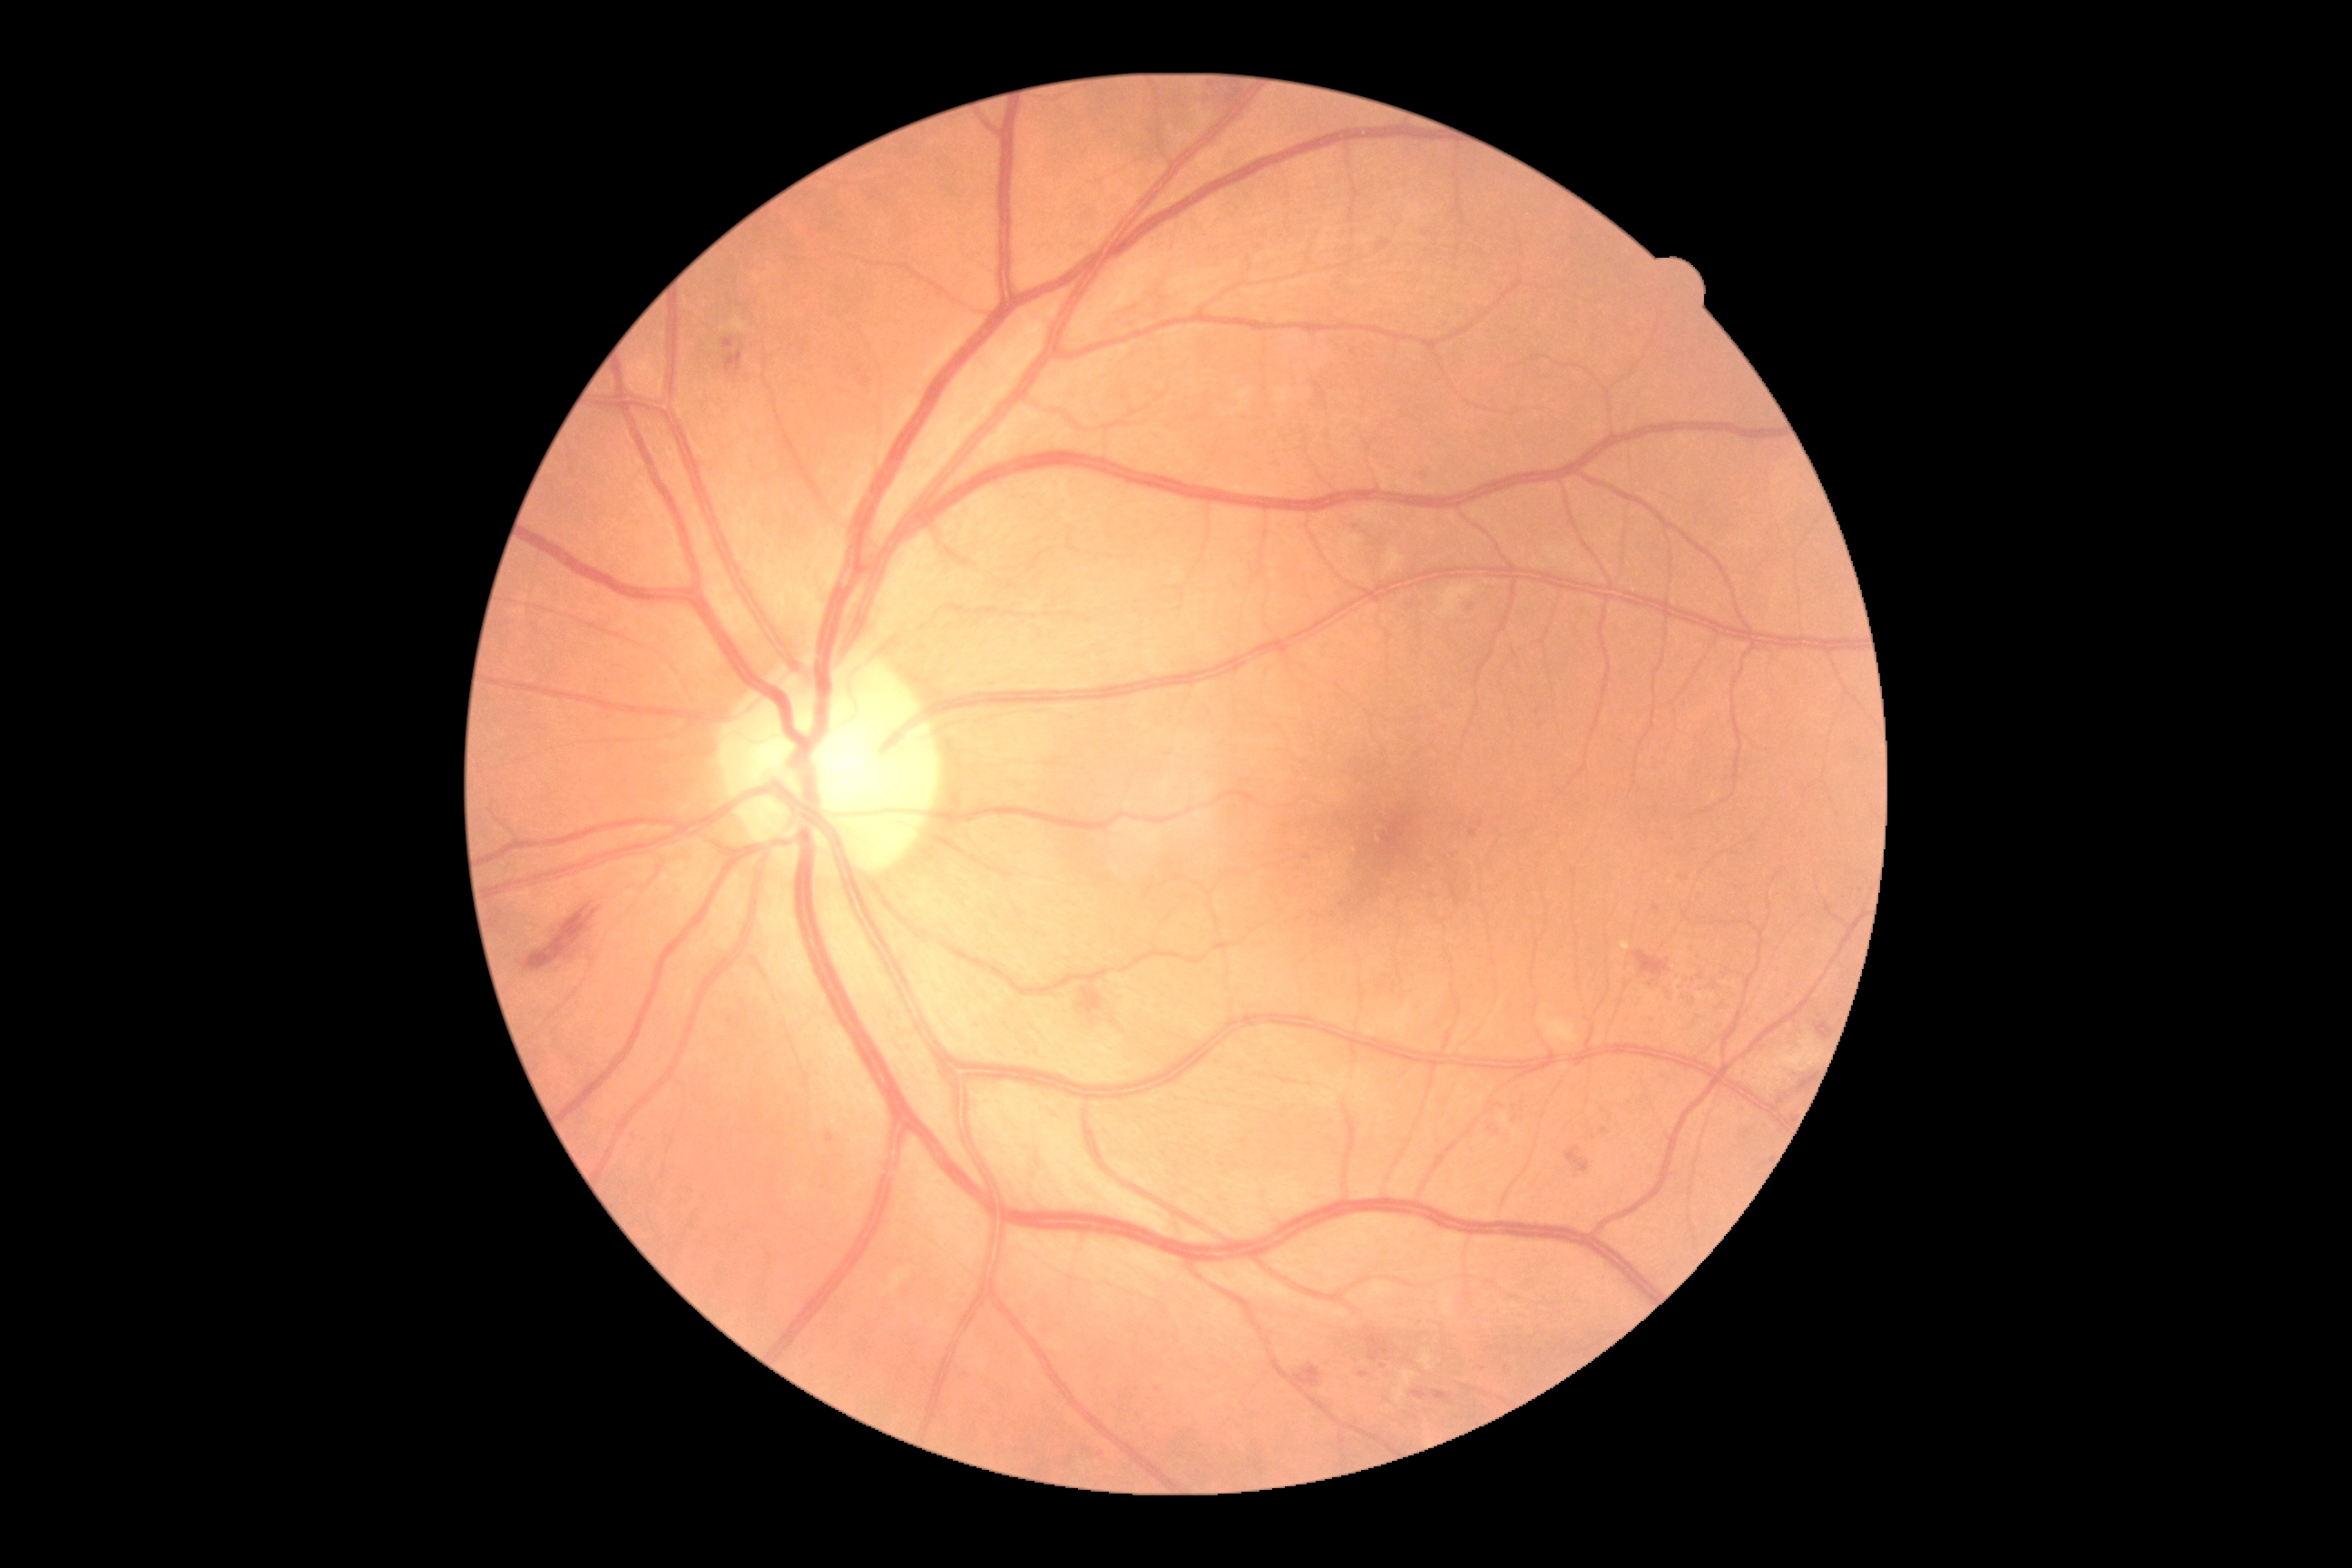
Diabetic retinopathy (DR): moderate NPDR (grade 2). DR class: non-proliferative diabetic retinopathy.